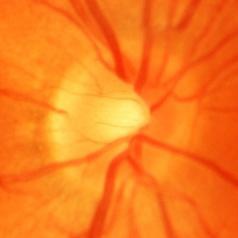 Diagnosis = glaucomatous changes.